2212x1659 — 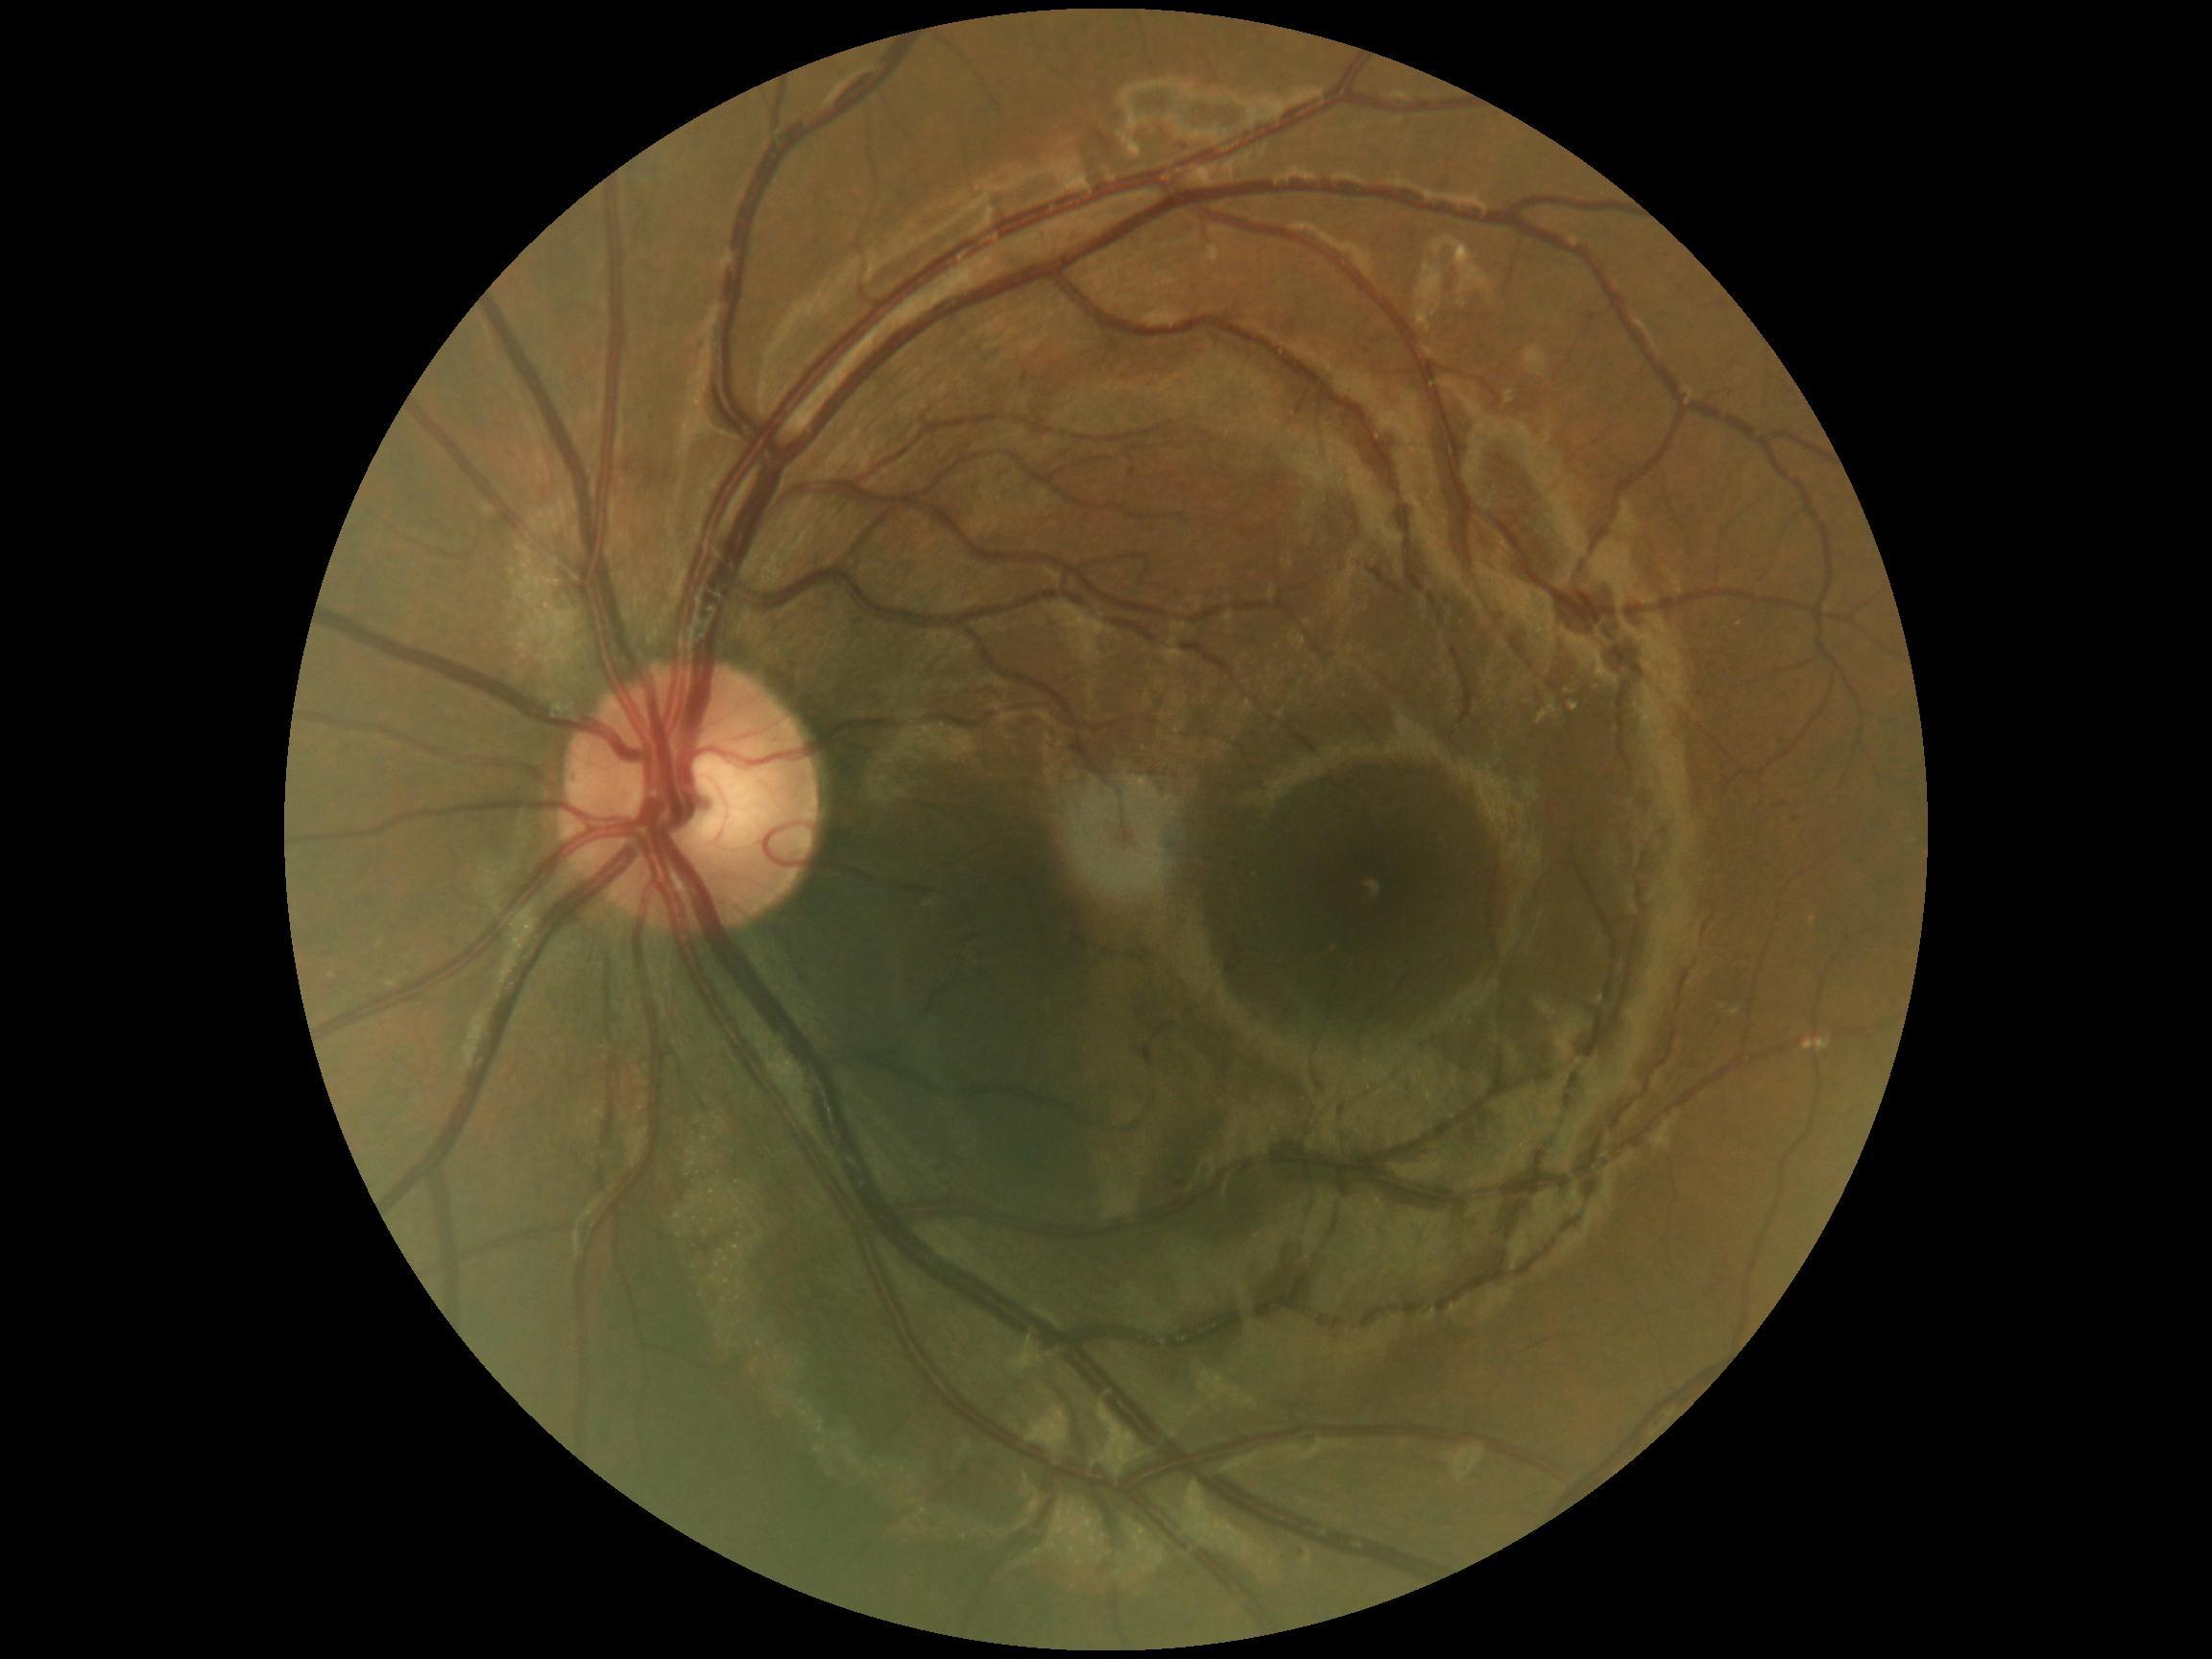 Diabetic retinopathy (DR): 0.